Image size 640x480 · wide-field contact fundus photograph of an infant.
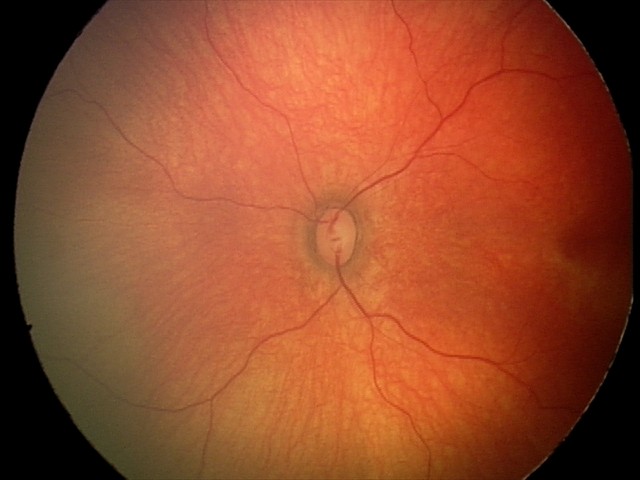

Screening examination diagnosed as physiological.